DR severity per modified Davis staging. NIDEK AFC-230. 848 by 848 pixels
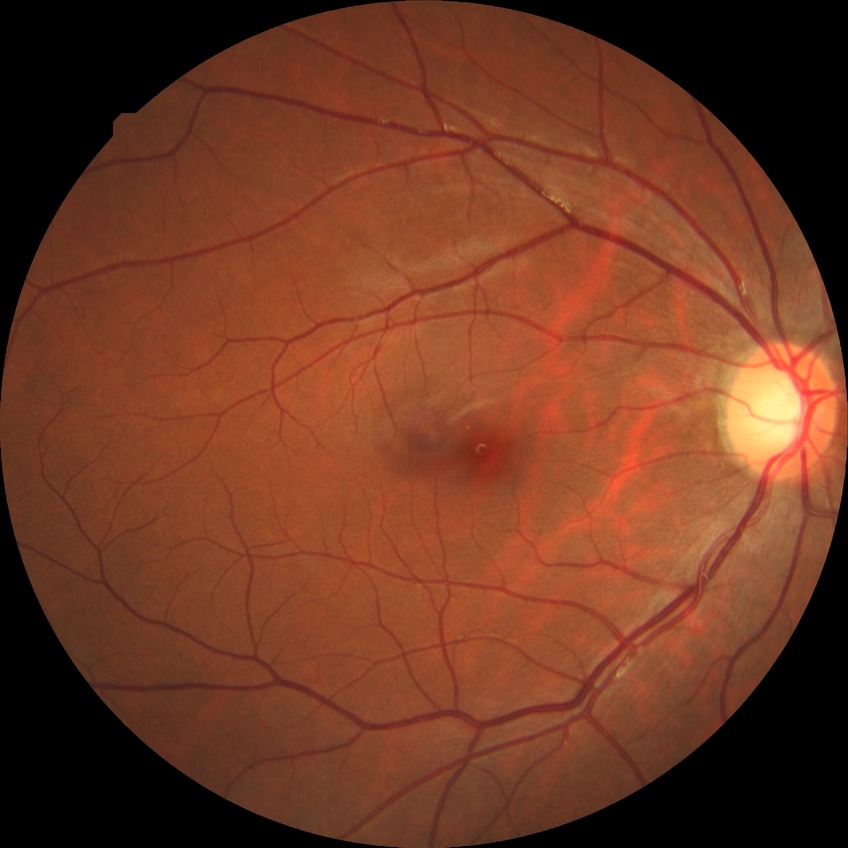 Diabetic retinopathy (DR) is no diabetic retinopathy (NDR).